Optic disc photograph.
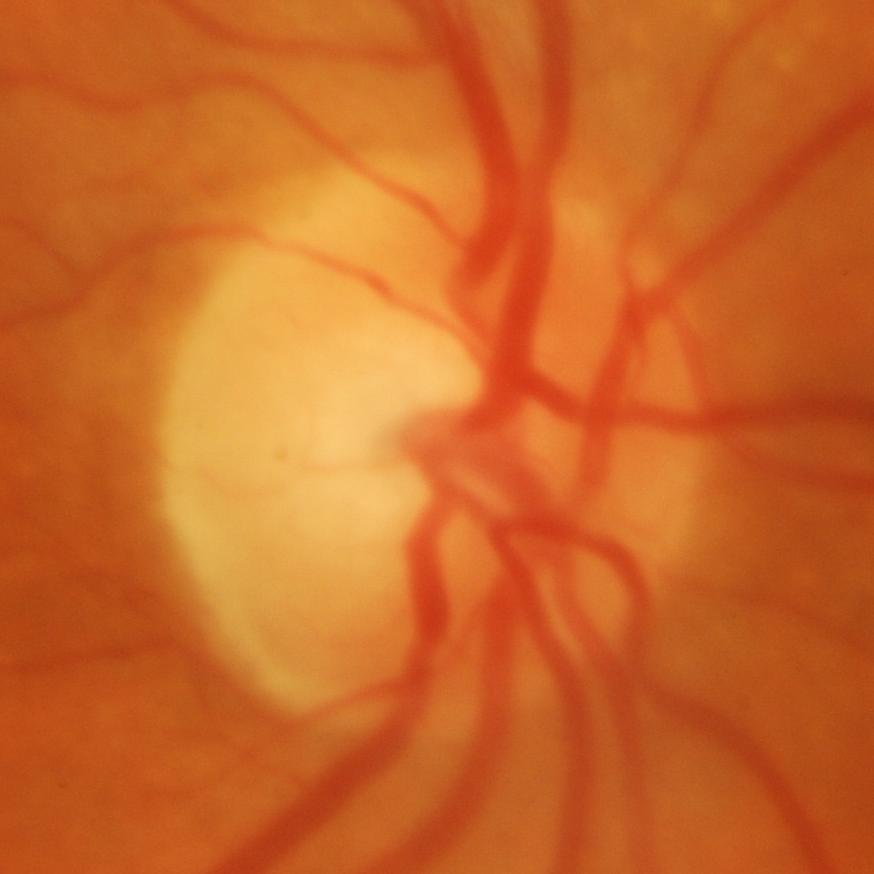 Glaucomatous damage to the optic nerve.